Infant wide-field fundus photograph. Camera: Phoenix ICON (100° FOV) — 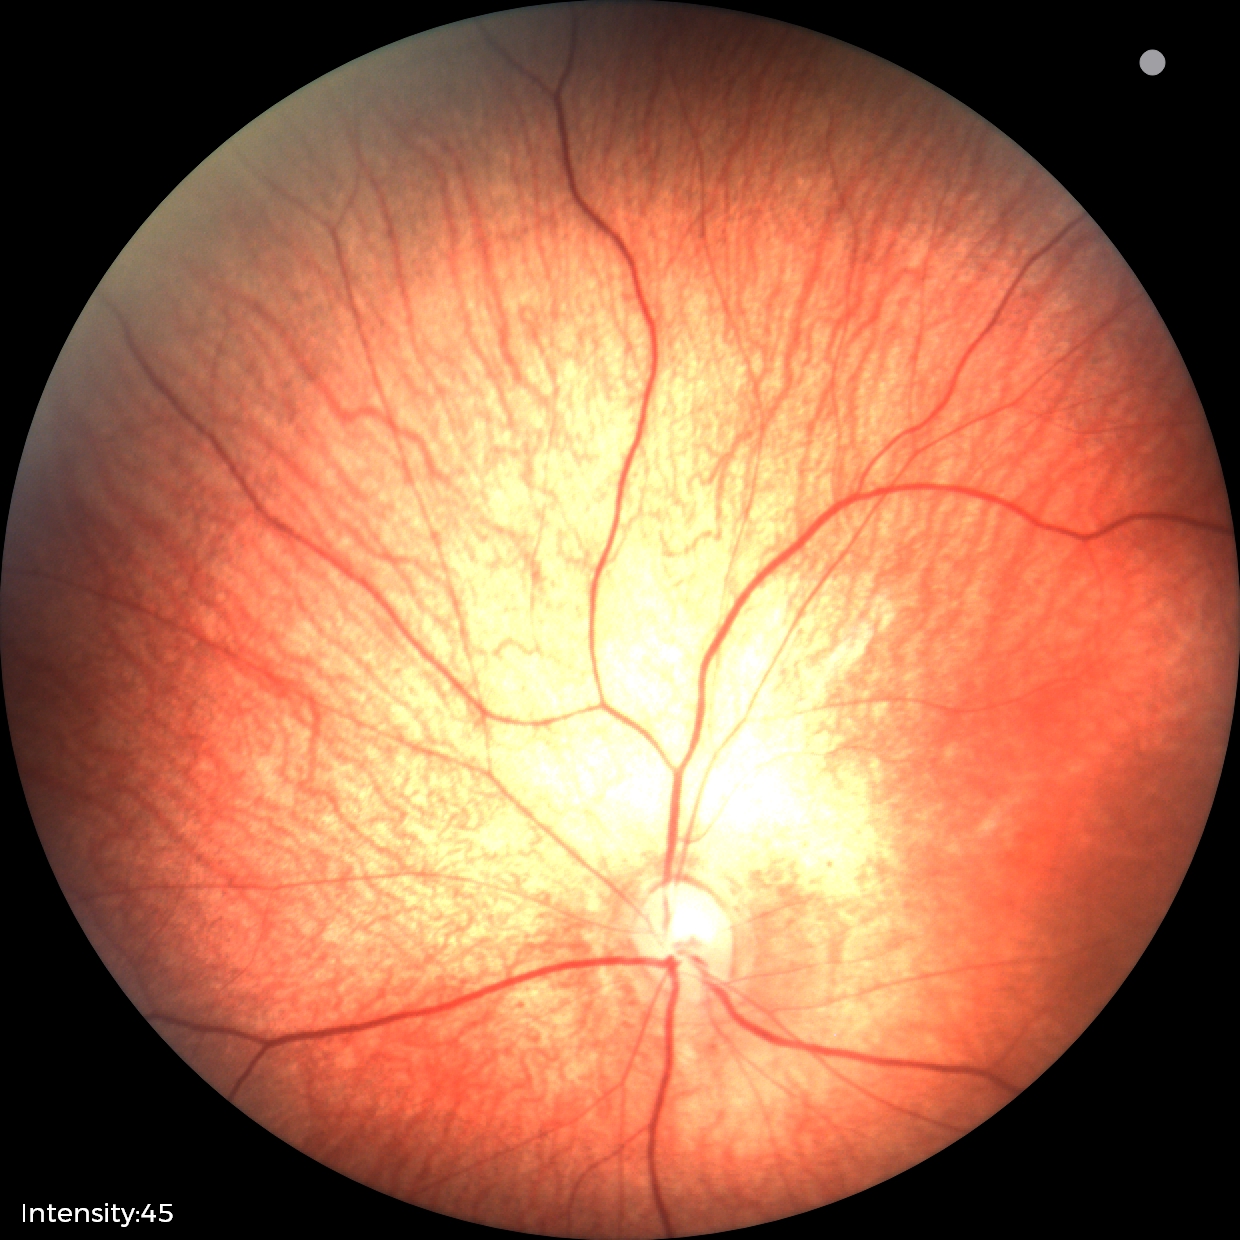 Physiological retinal appearance for postconceptual age.